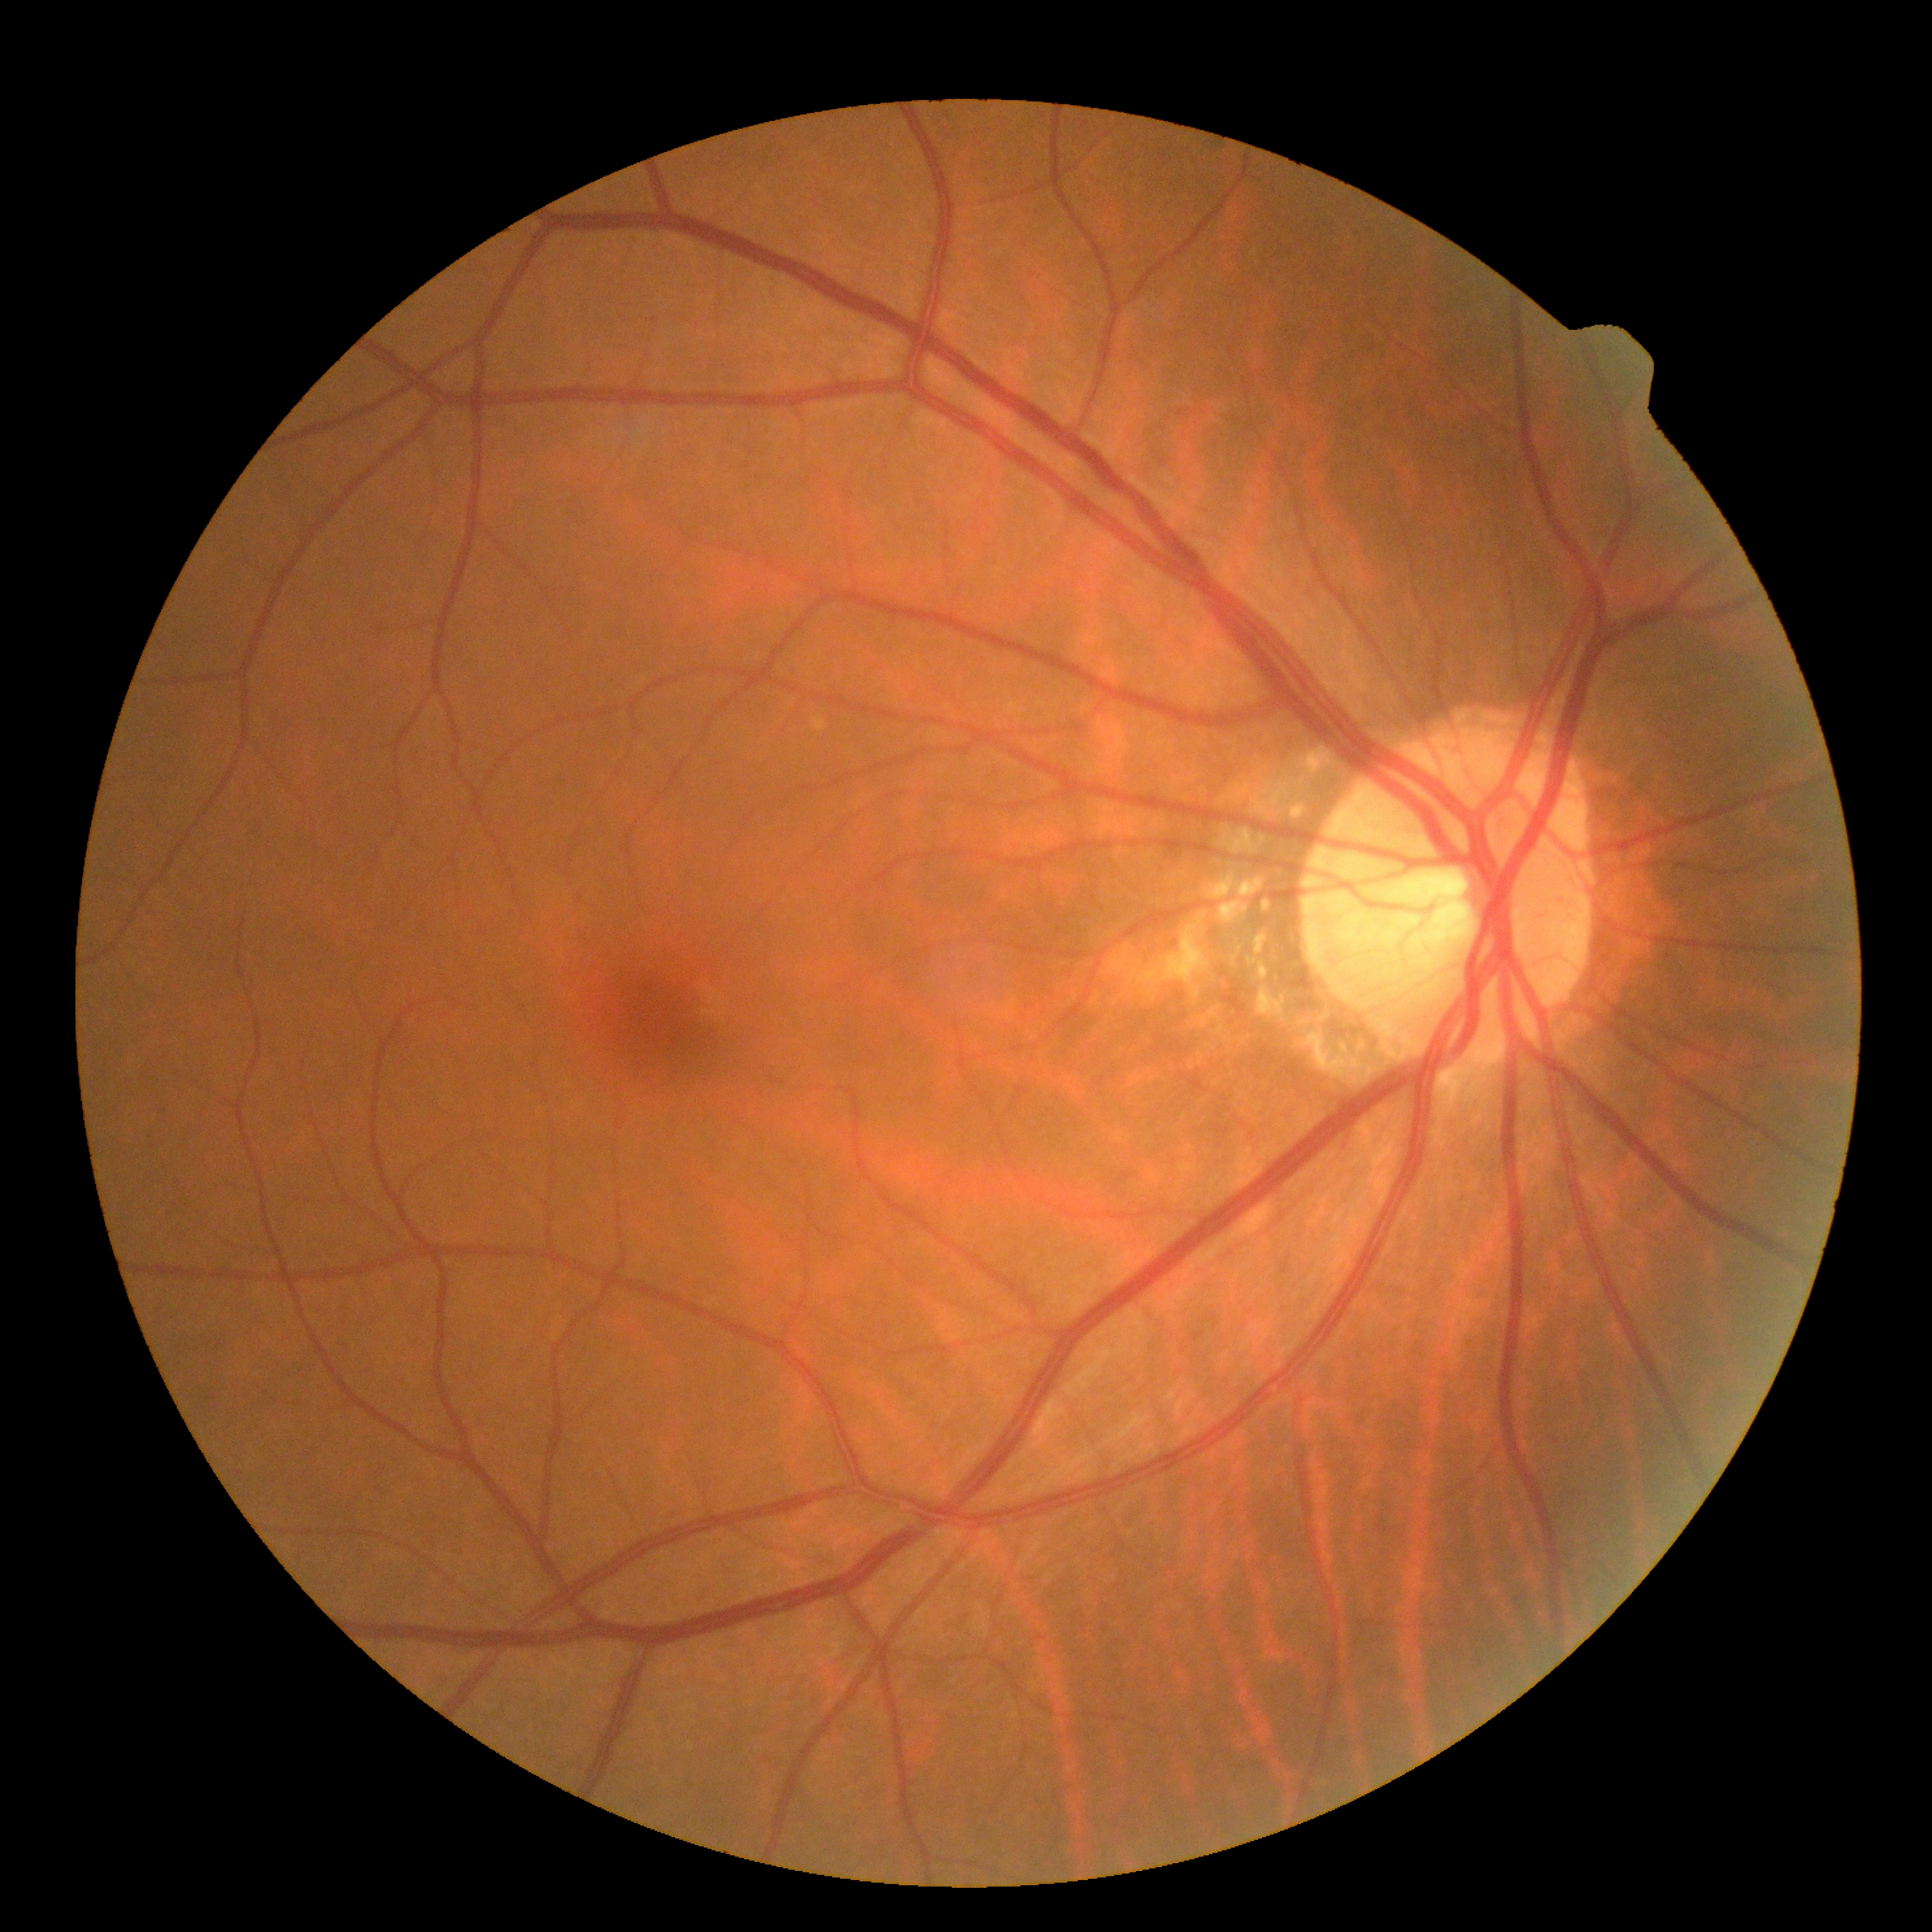 diabetic retinopathy grade: no apparent retinopathy (0) — no visible signs of diabetic retinopathy.